45° FOV. Color fundus photograph. Camera: NIDEK AFC-230
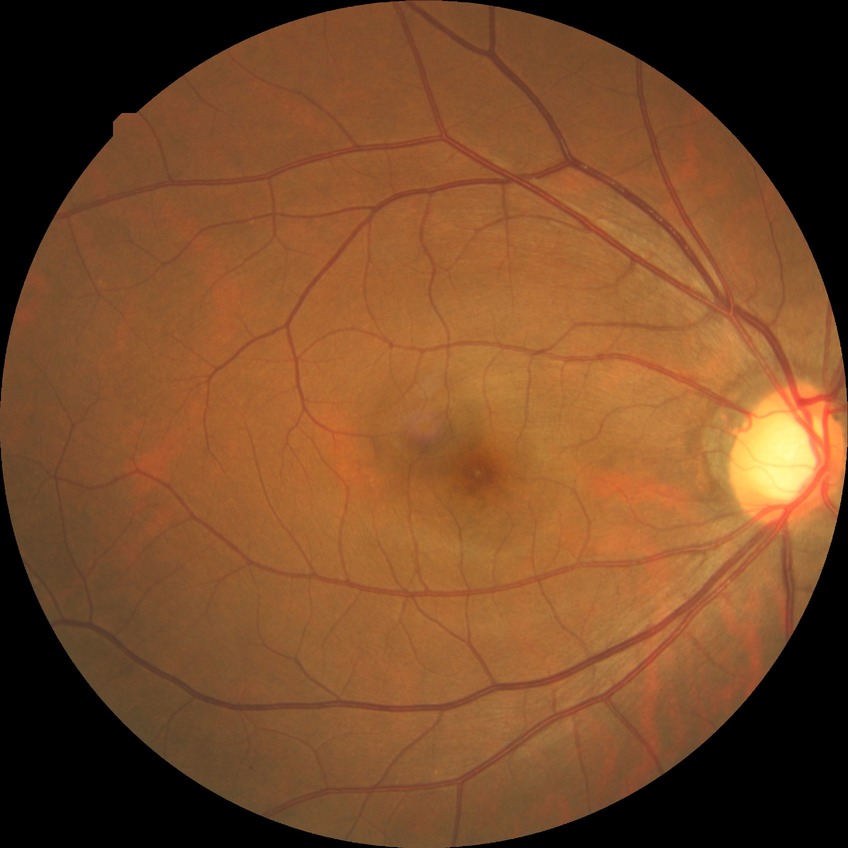

Diabetic retinopathy stage: no diabetic retinopathy.